1920 by 1440 pixels.
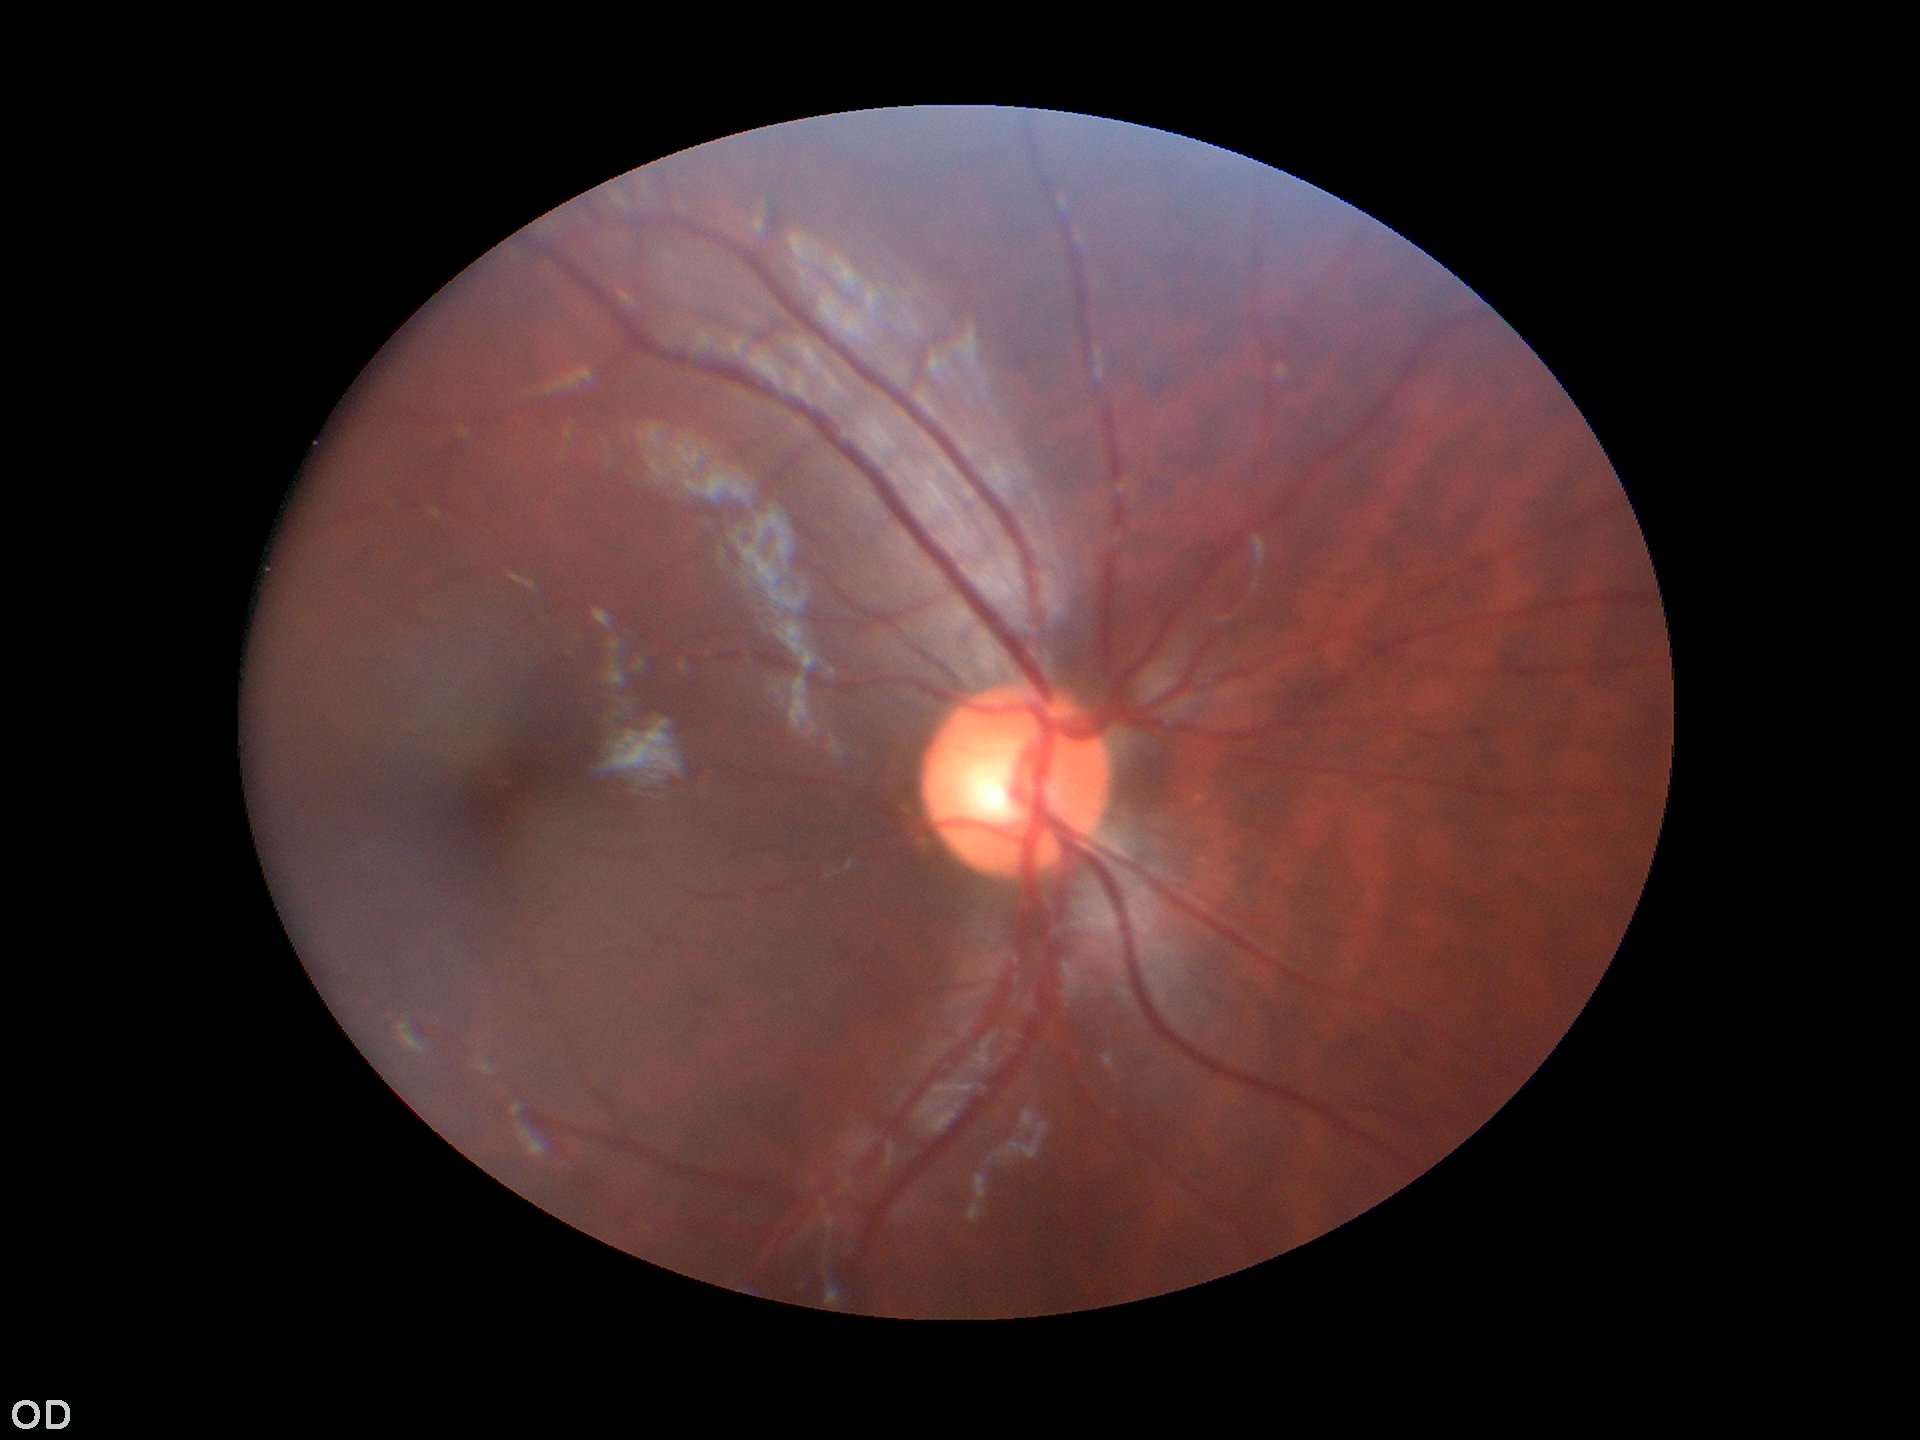
No evidence of glaucoma.
Vertical CDR (VCDR): 0.52.